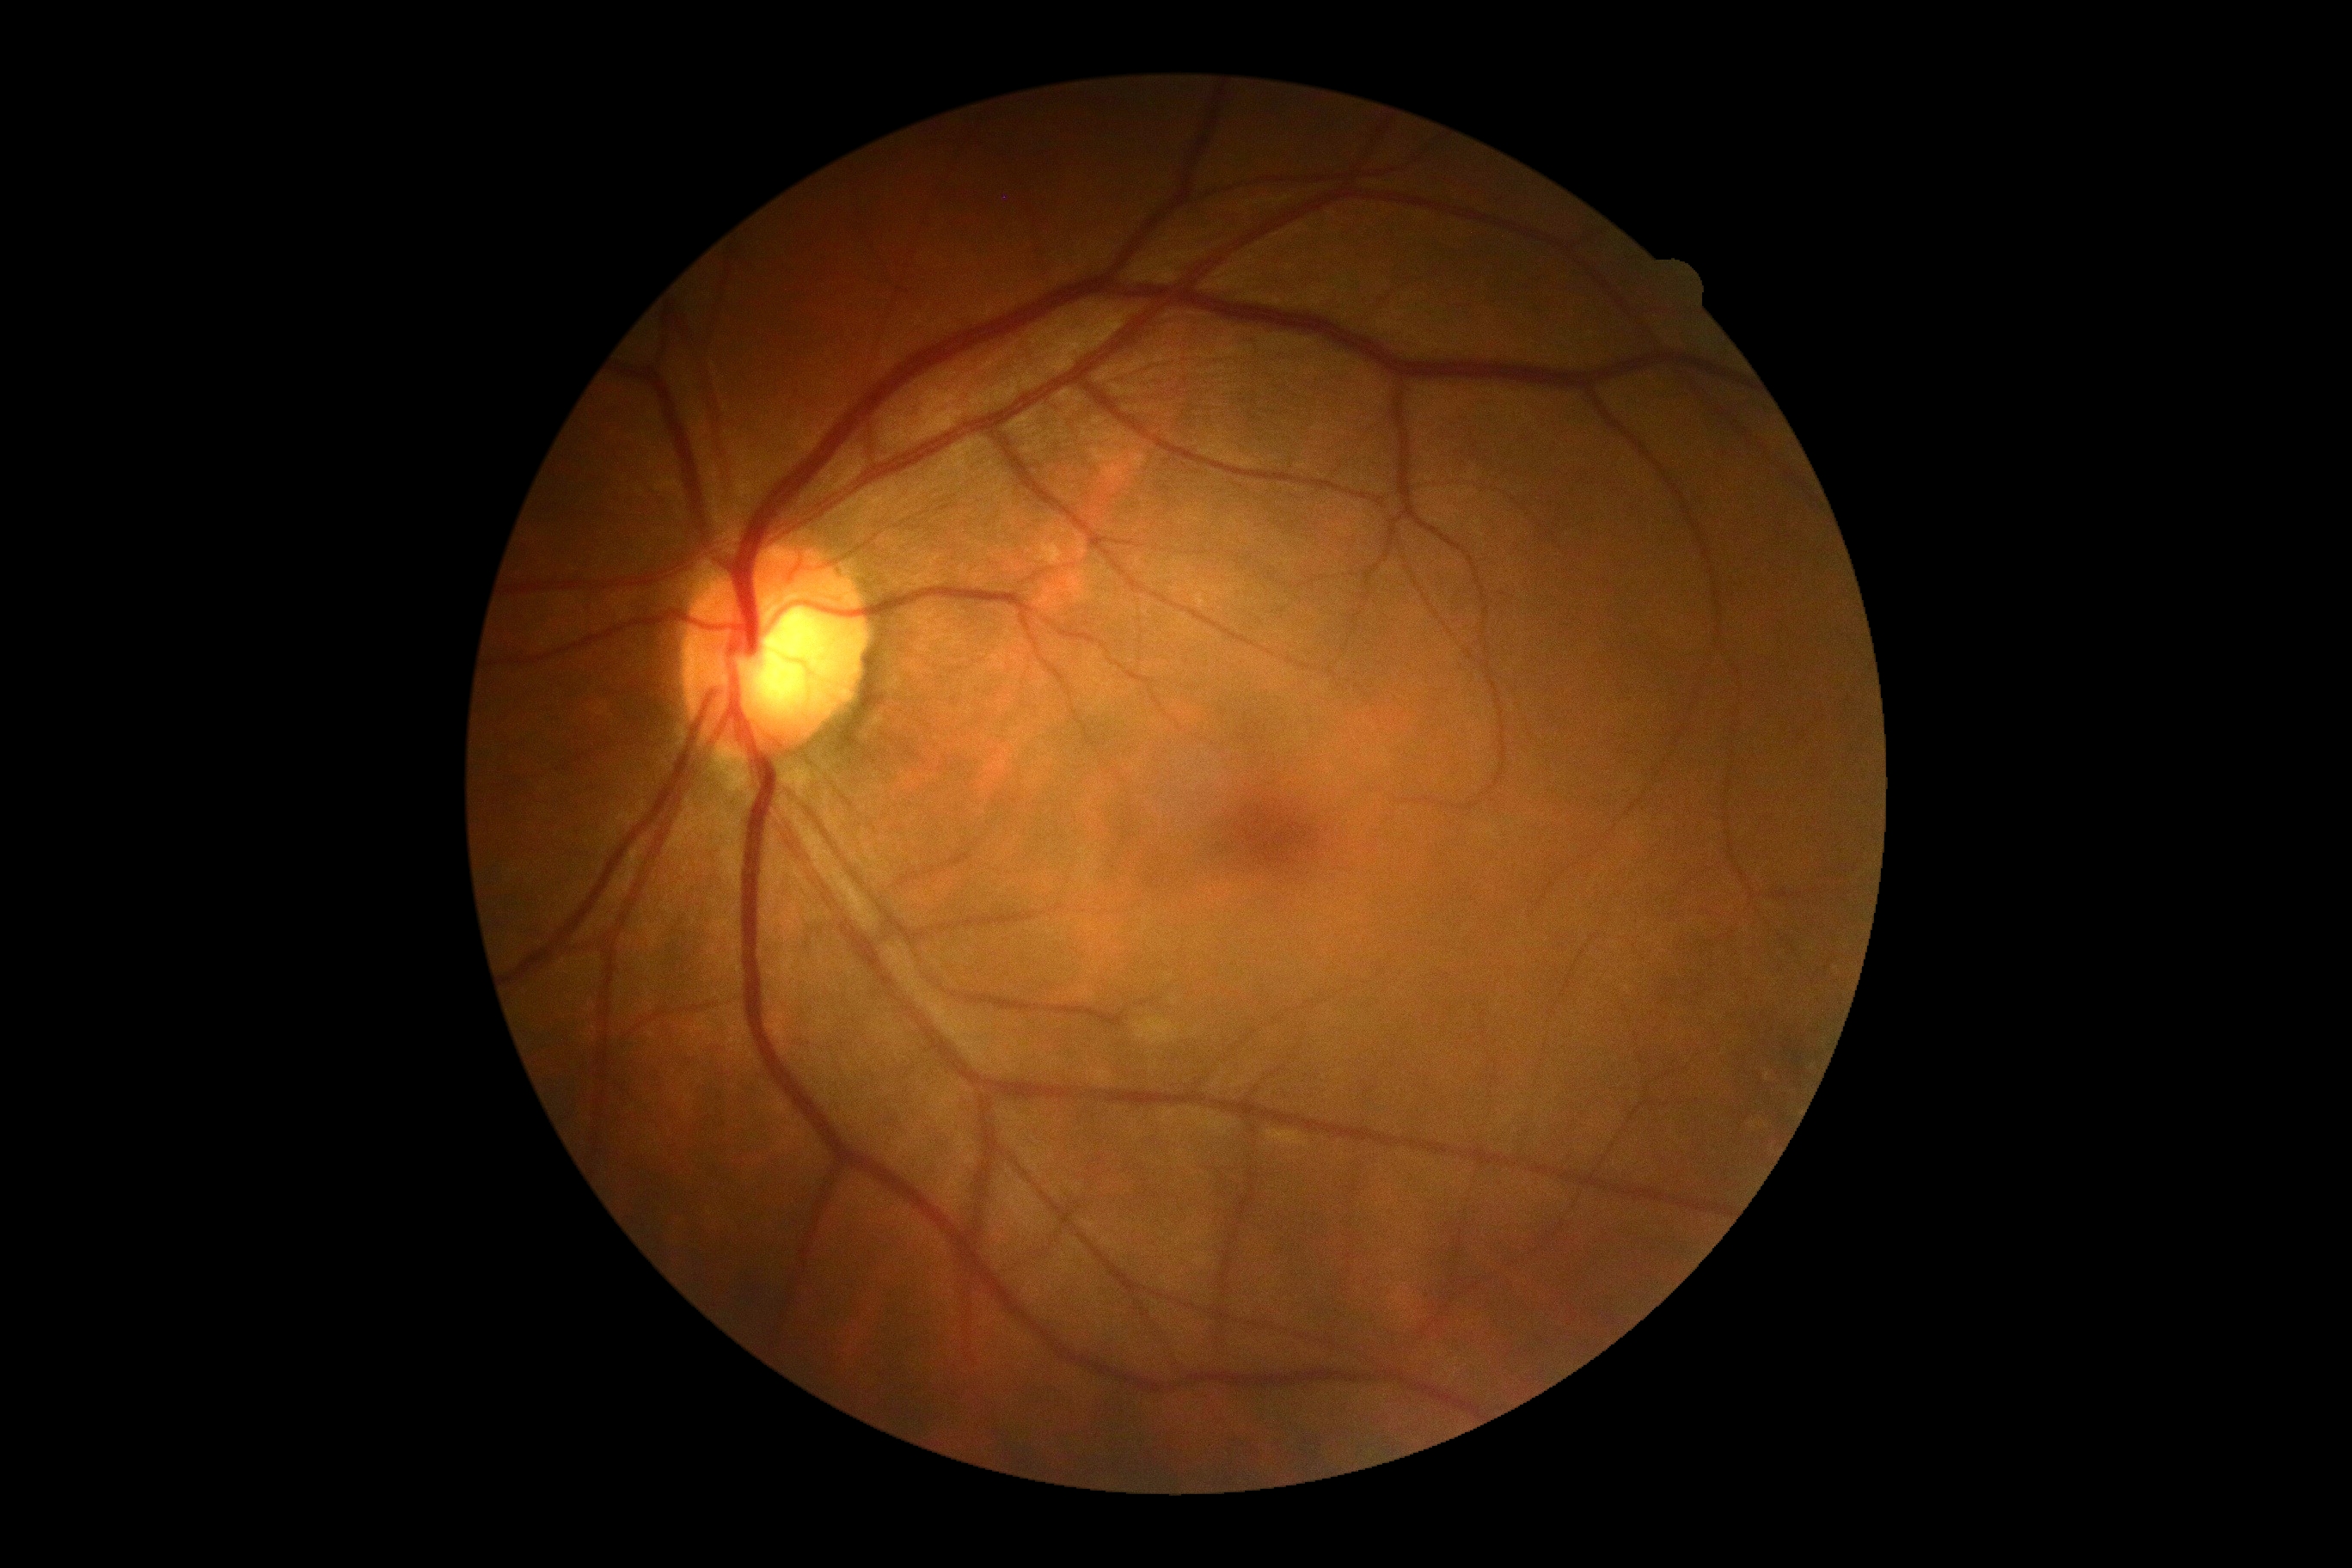 DR stage: no apparent diabetic retinopathy (grade 0).
No DR findings.